Color fundus photograph centered on the optic disc.
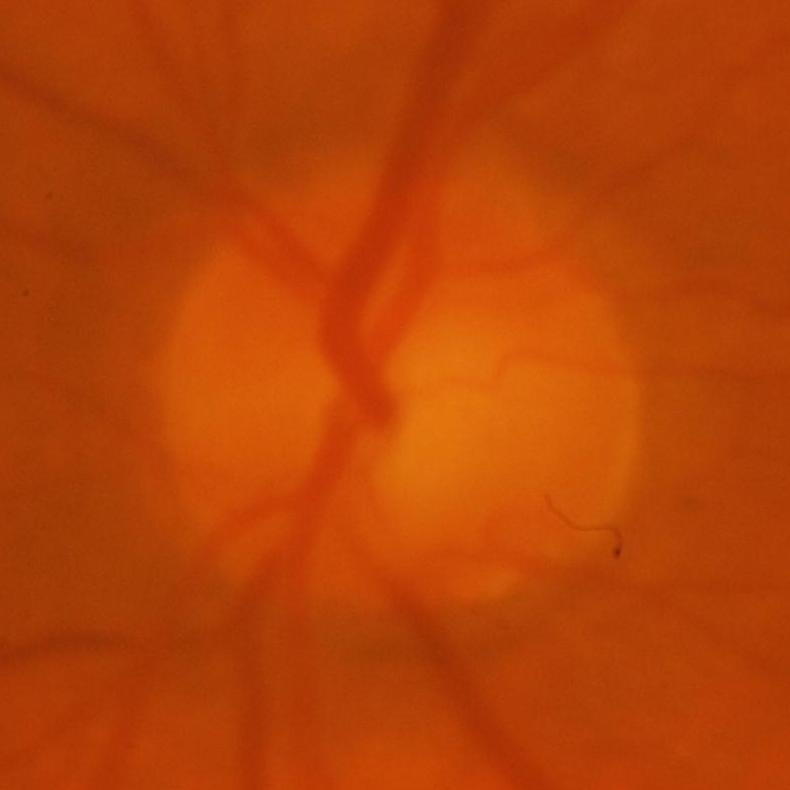

Glaucoma assessment: glaucomatous changes.